FOV: 45 degrees:
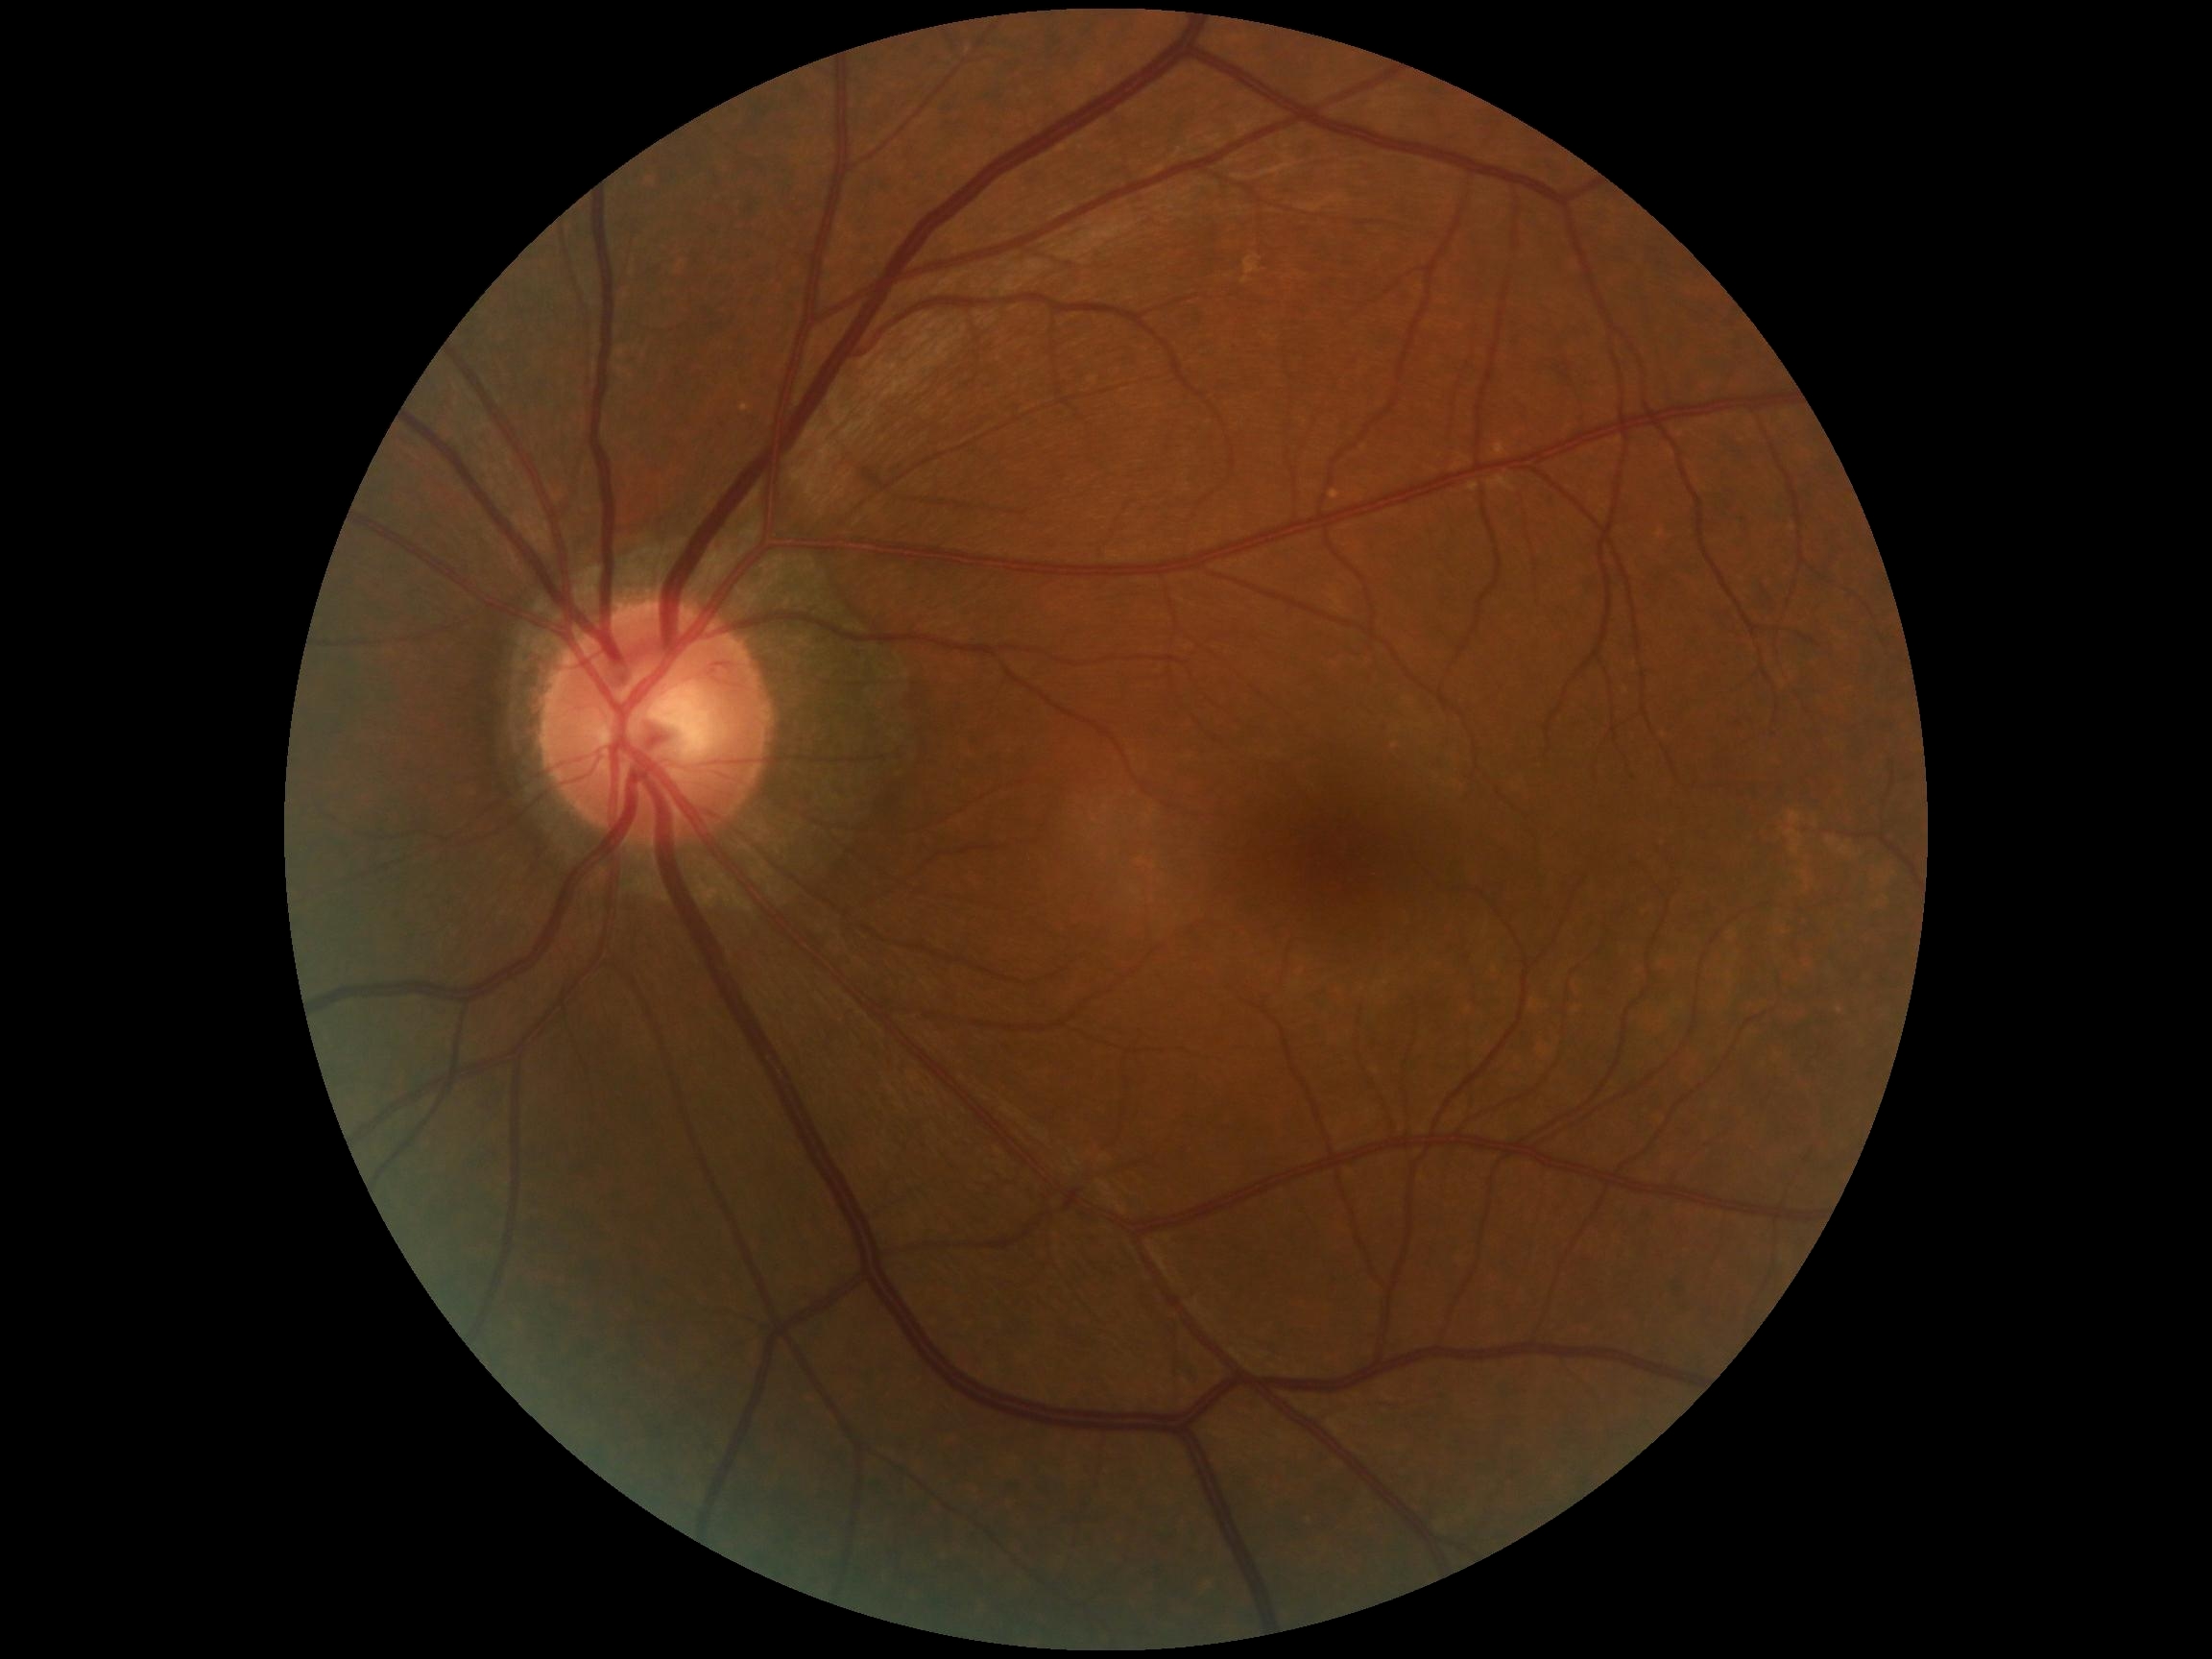 DR stage is 0/4. No signs of diabetic retinopathy.